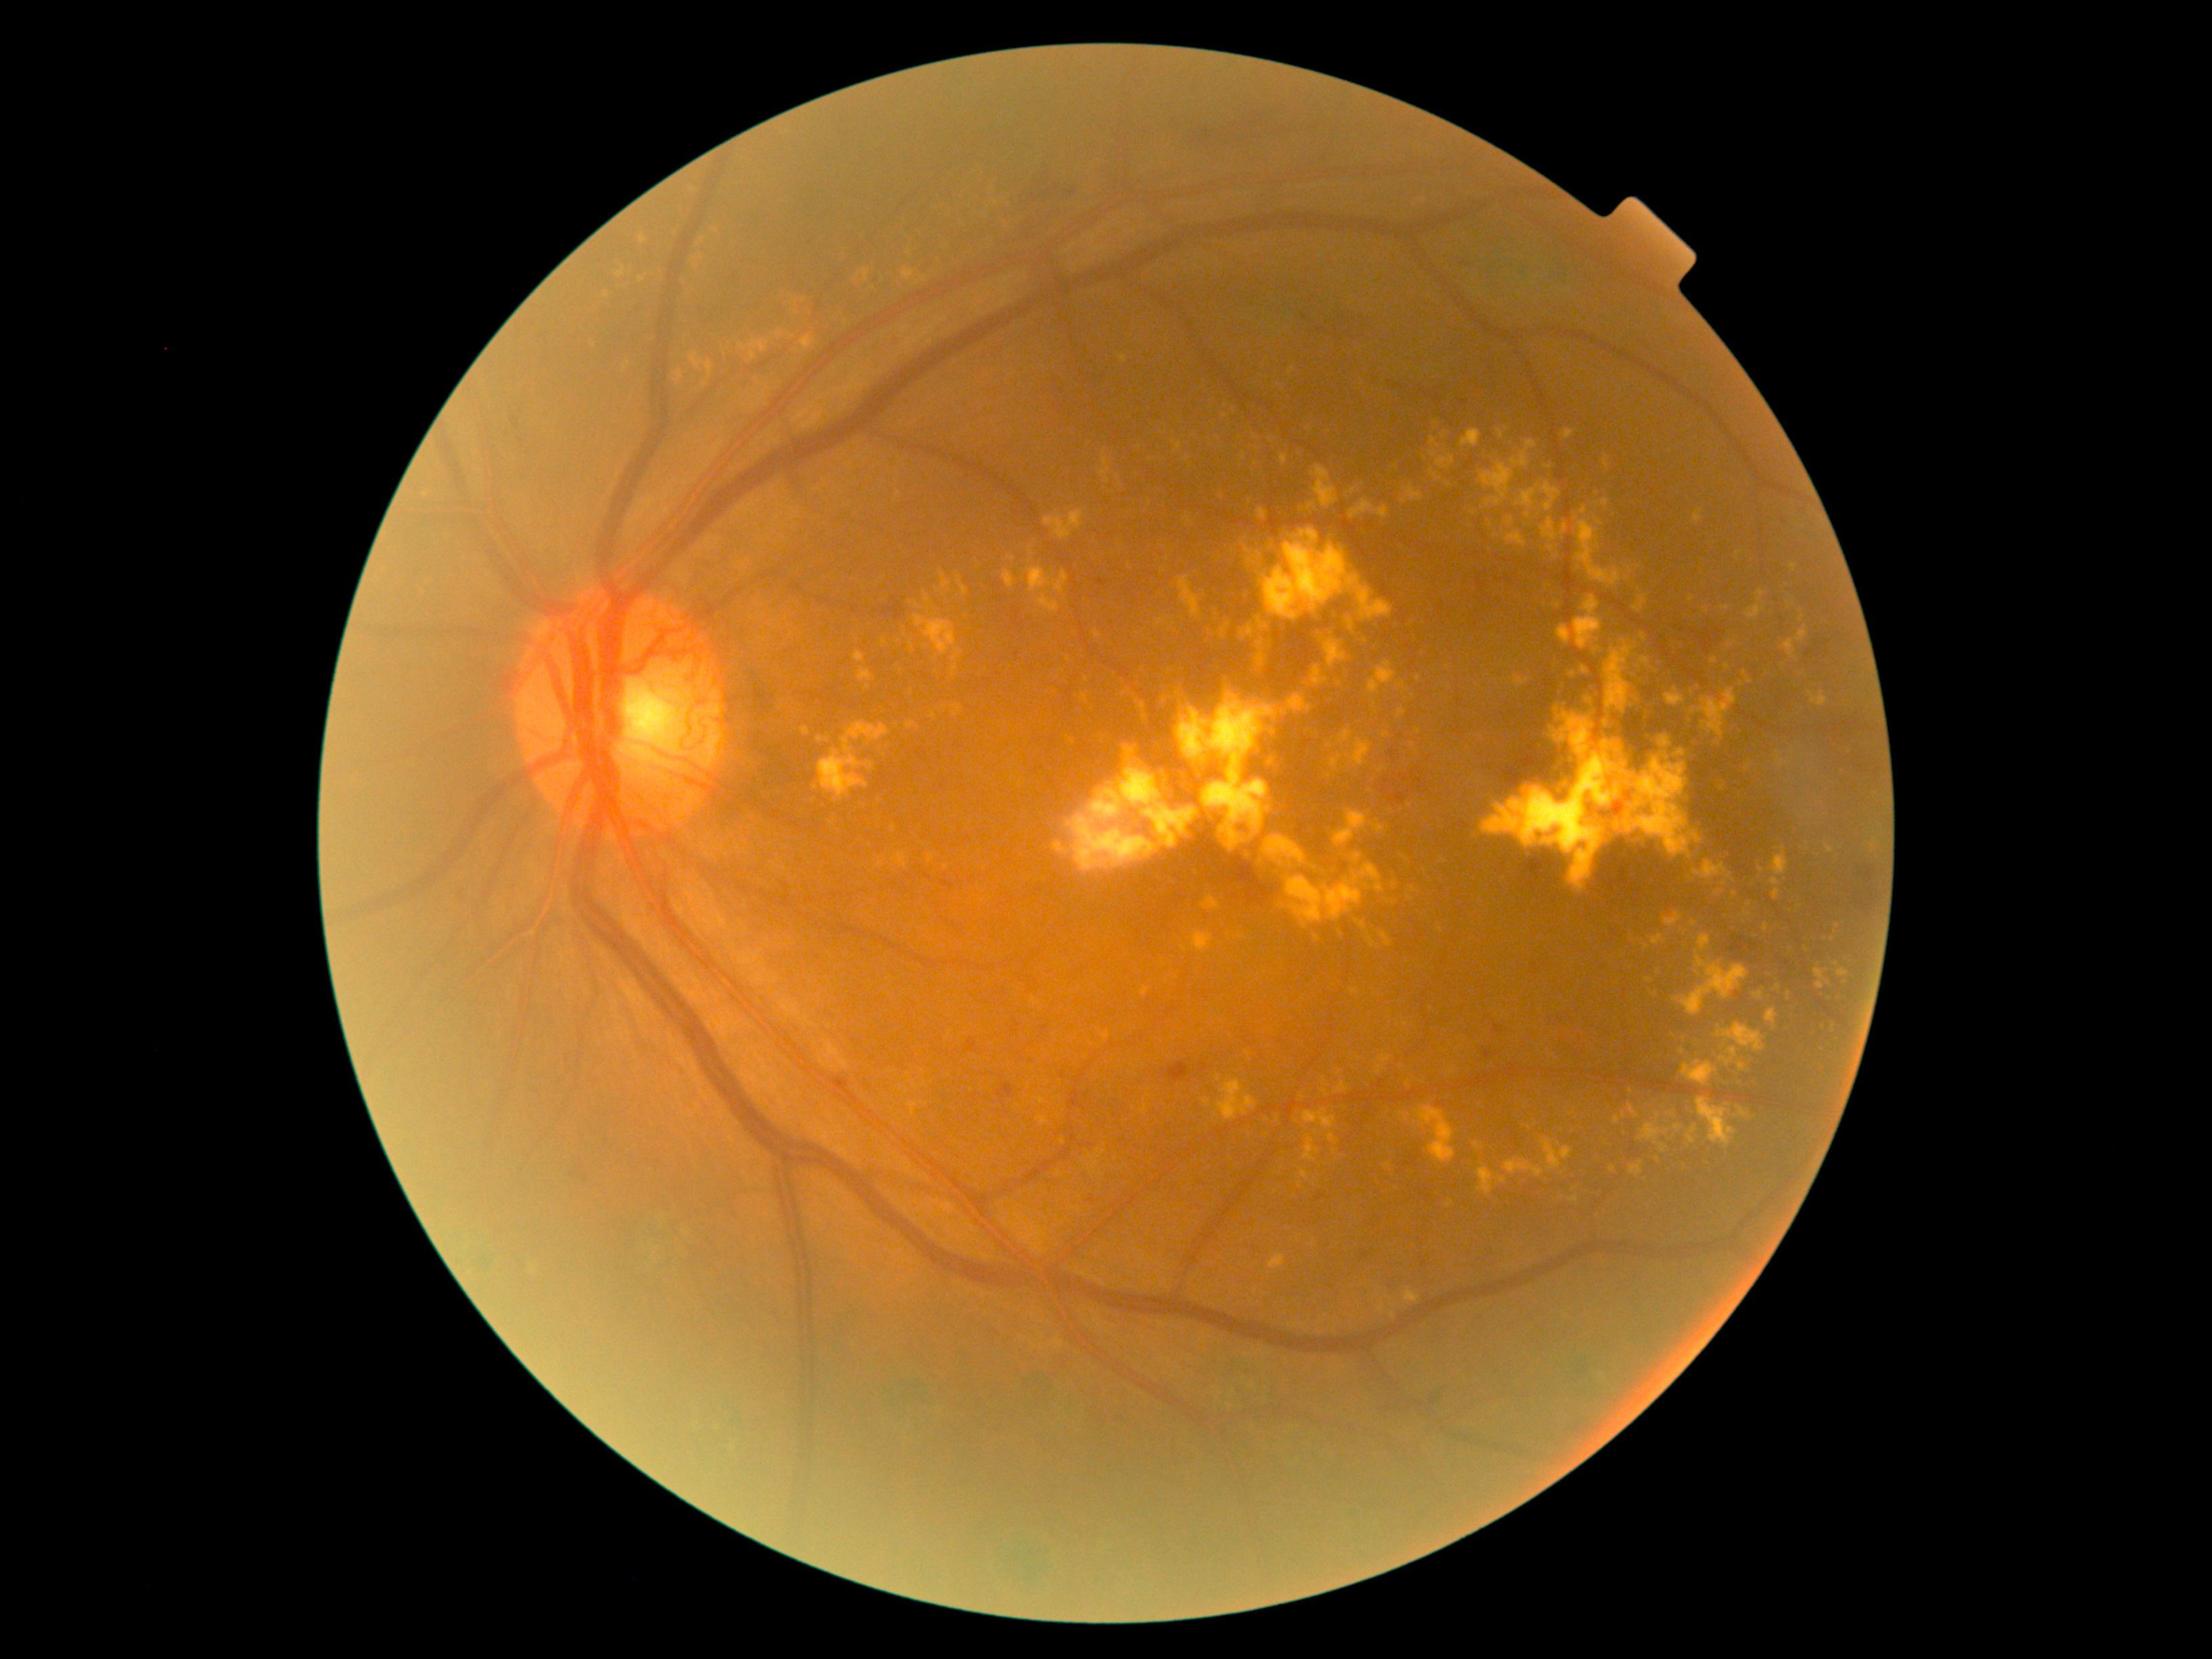 partial: true
dr_grade: 4
dr_grade_name: PDR
lesions:
  se: []
  ex:
    - (1574,597,1603,651)
    - (1441,432,1450,437)
    - (1679,798,1692,807)
    - (1337,726,1353,746)
    - (1481,742,1633,891)
    - (1398,710,1406,718)
    - (1431,437,1440,448)
    - (1540,482,1561,512)
    - (1799,612,1805,623)
    - (1633,796,1650,810)
    - (1141,989,1150,997)
    - (1668,1112,1676,1116)
    - (1242,555,1260,565)
  ex_small:
    - pt(1041, 1101)
    - pt(1393, 1315)
    - pt(742, 348)
    - pt(674, 235)
    - pt(1648, 980)
    - pt(717, 232)
    - pt(1747, 769)
  ma:
    - (510,415,520,430)
    - (1315,1193,1326,1202)
    - (1626,792,1631,800)
    - (1361,1250,1370,1261)
    - (1493,1025,1504,1035)
    - (964,1038,981,1054)
    - (1096,578,1107,586)
    - (1483,1048,1493,1061)
    - (1317,326,1326,333)
    - (997,1084,1015,1104)
  ma_small:
    - pt(1306, 317)
    - pt(1117, 1420)
  he:
    - (501,677,517,692)
    - (1193,108,1277,140)
    - (1856,865,1875,886)
    - (1164,1062,1189,1082)
    - (1428,1399,1440,1416)
    - (1750,943,1759,952)
    - (1387,386,1399,390)
    - (1431,388,1447,398)
    - (1394,791,1408,807)
    - (829,1077,853,1094)
    - (1017,213,1061,242)
    - (1417,779,1427,792)
  he_small:
    - pt(1410, 792)